45° FOV, retinal fundus photograph: 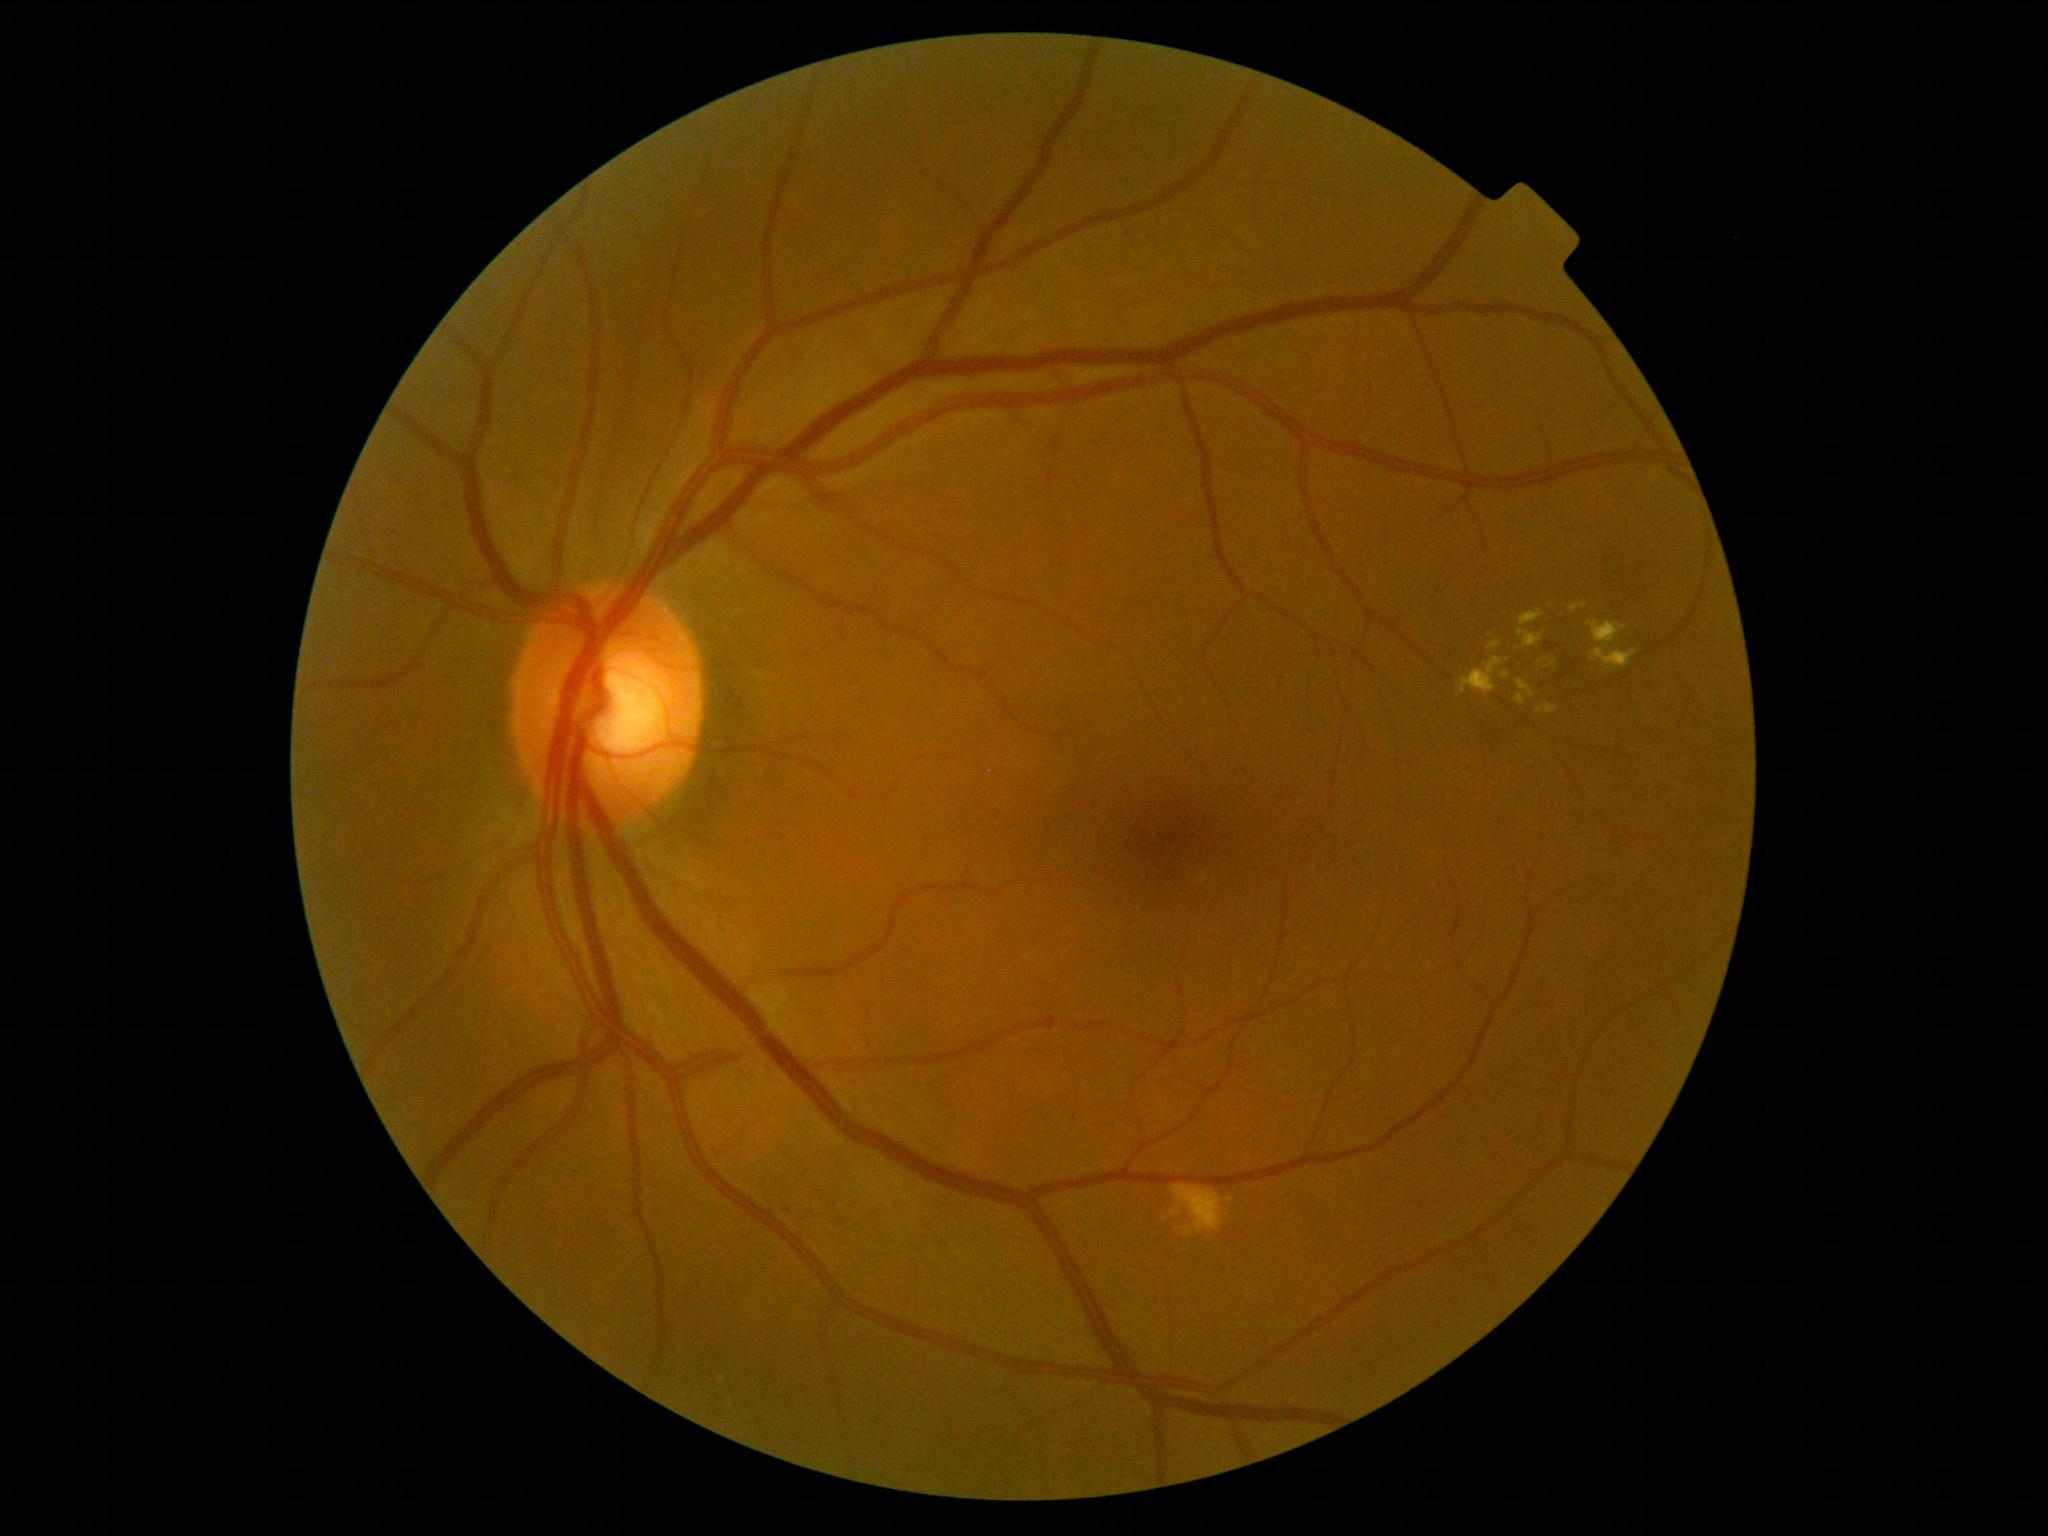 Diabetic retinopathy (DR): grade 2
Representative lesions:
soft exudates (SEs): none detected
hemorrhages (HEs): <bbox>1547, 640, 1556, 652</bbox>, <bbox>1542, 655, 1577, 686</bbox>
hard exudates (EXs) (continued): <bbox>1590, 647, 1639, 670</bbox>, <bbox>1569, 603, 1589, 615</bbox>, <bbox>1516, 679, 1536, 699</bbox>, <bbox>1489, 642, 1502, 650</bbox>, <bbox>1502, 672, 1510, 679</bbox>, <bbox>1459, 657, 1510, 698</bbox>, <bbox>1519, 630, 1545, 649</bbox>, <bbox>1516, 693, 1526, 706</bbox>, <bbox>1536, 703, 1560, 715</bbox>, <bbox>1520, 610, 1545, 626</bbox>, <bbox>1588, 620, 1628, 643</bbox>
EXs (small, approximate centers) near (x=1552, y=662), (x=1551, y=606)
MAs (small, approximate centers) near (x=788, y=1211)